2212x1672 · 45° field of view
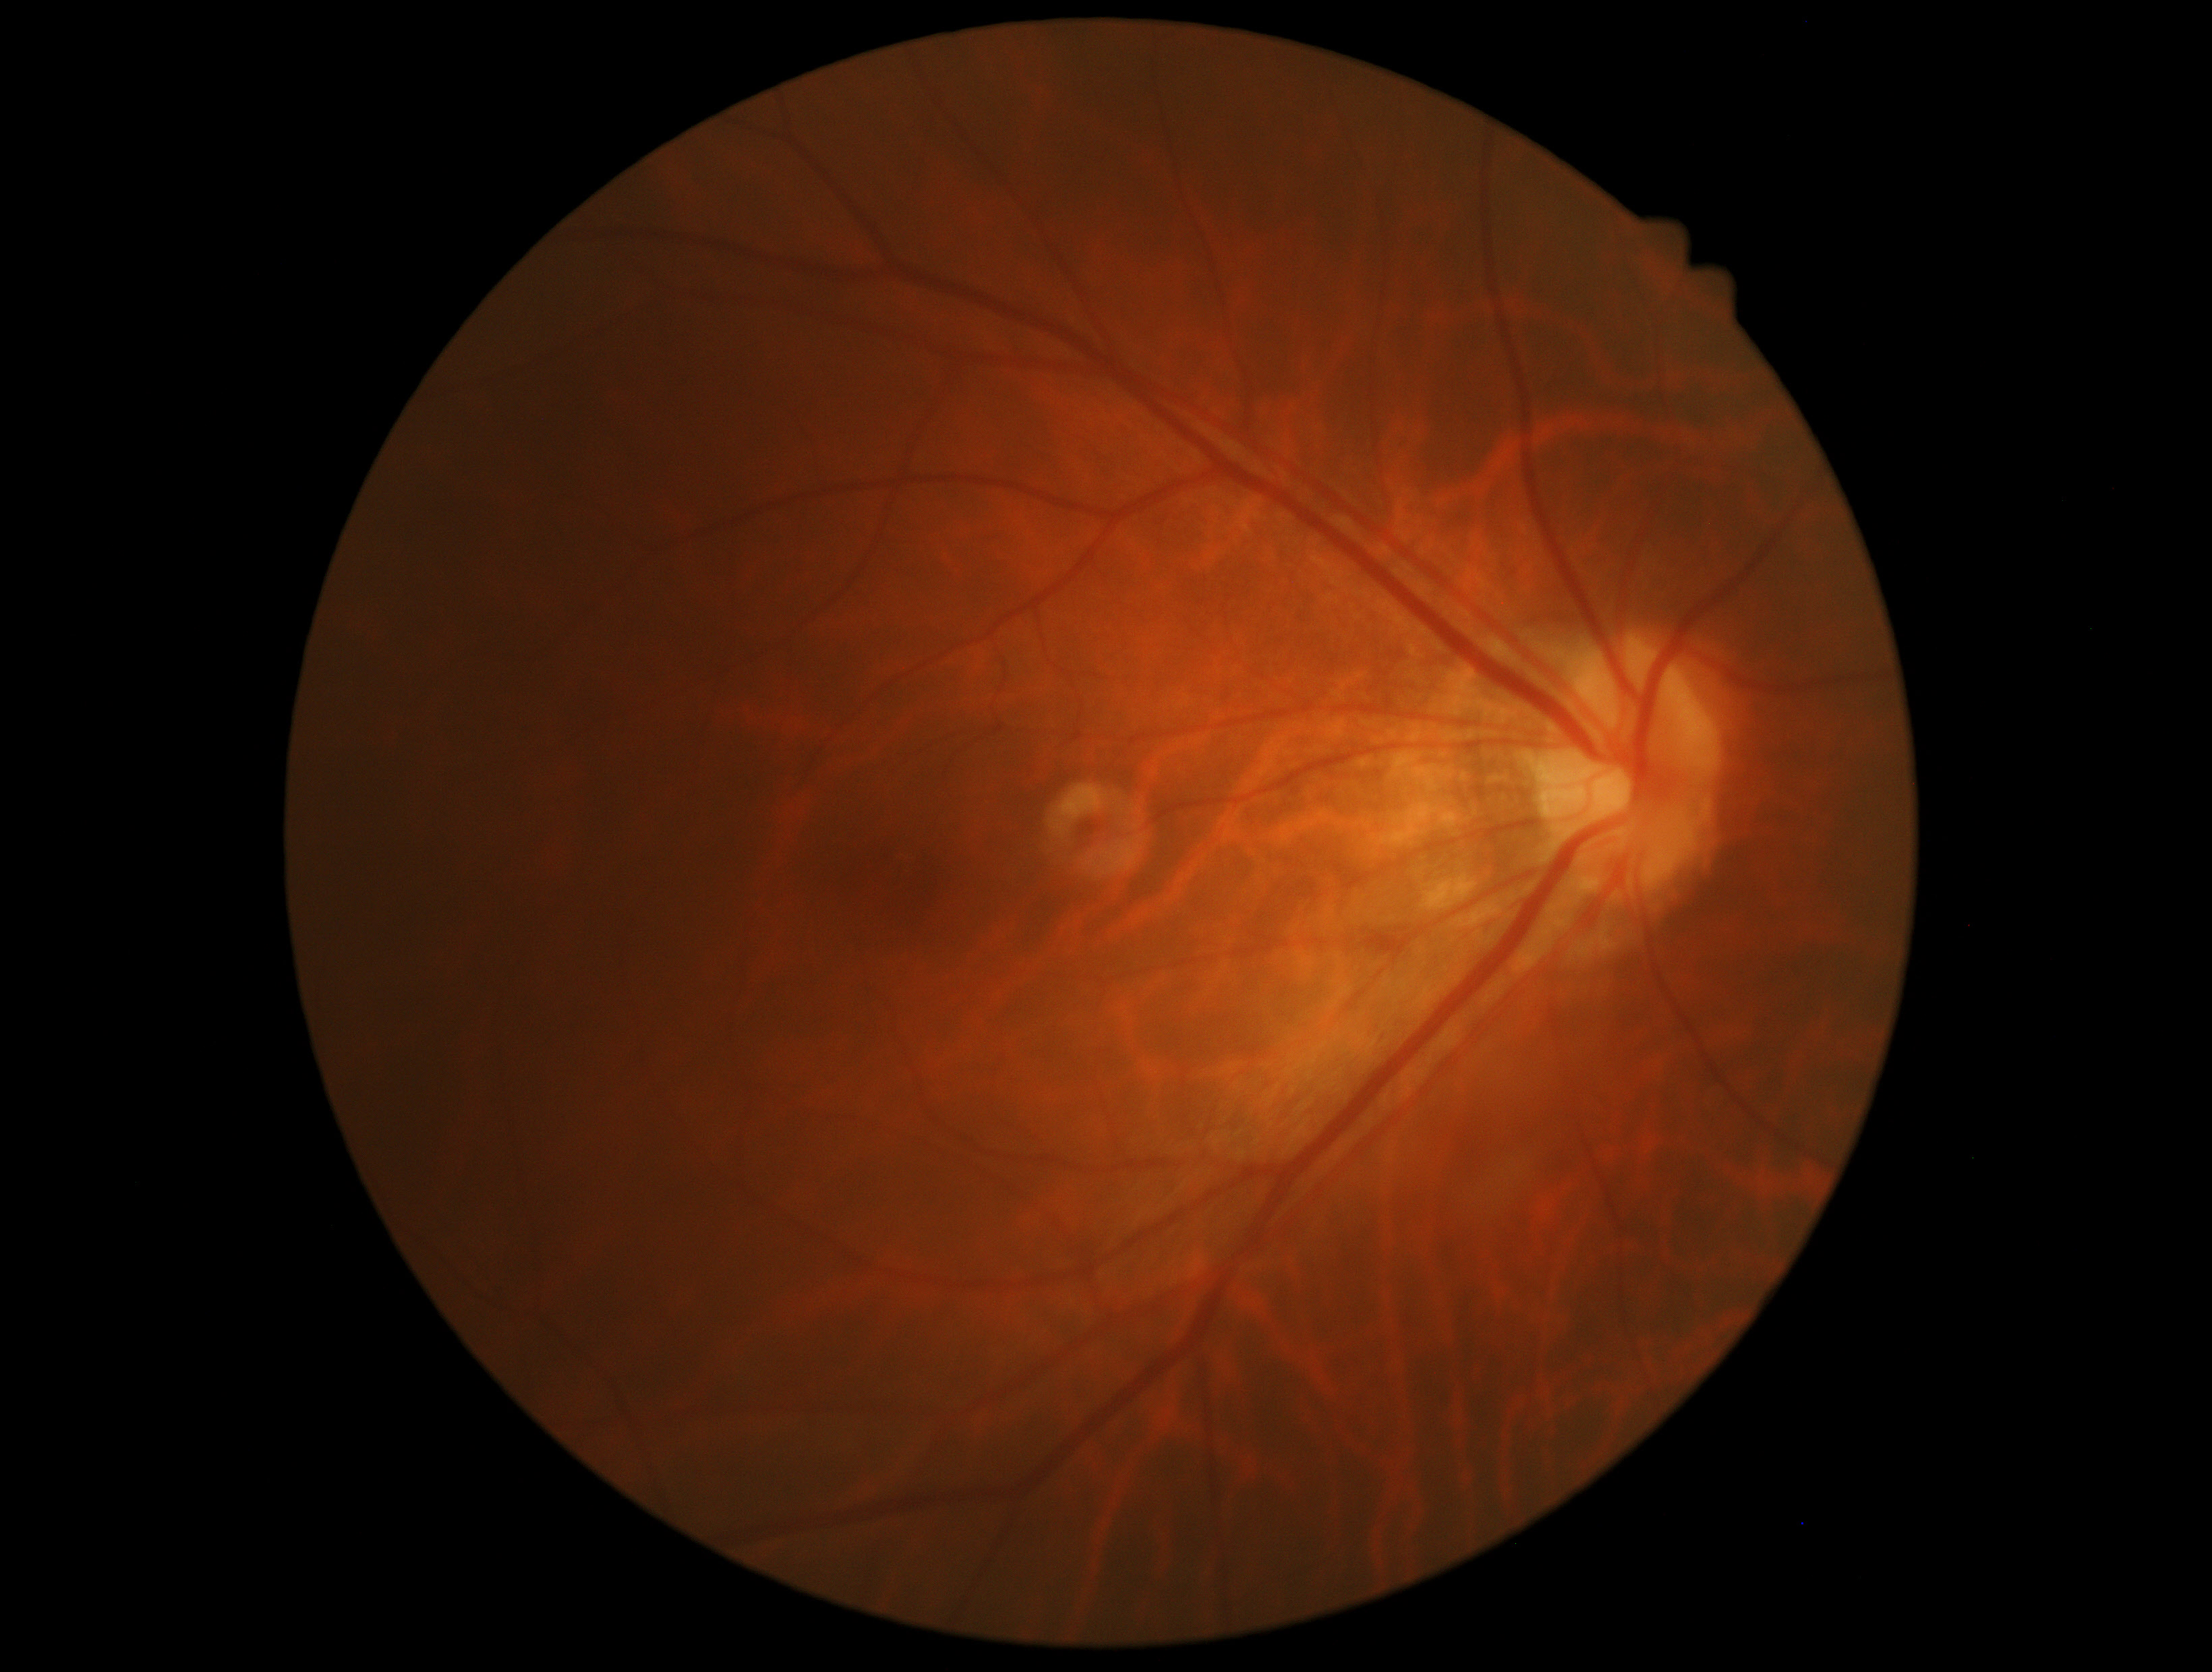 DR severity: no apparent diabetic retinopathy (grade 0).